Image size 2352x1568.
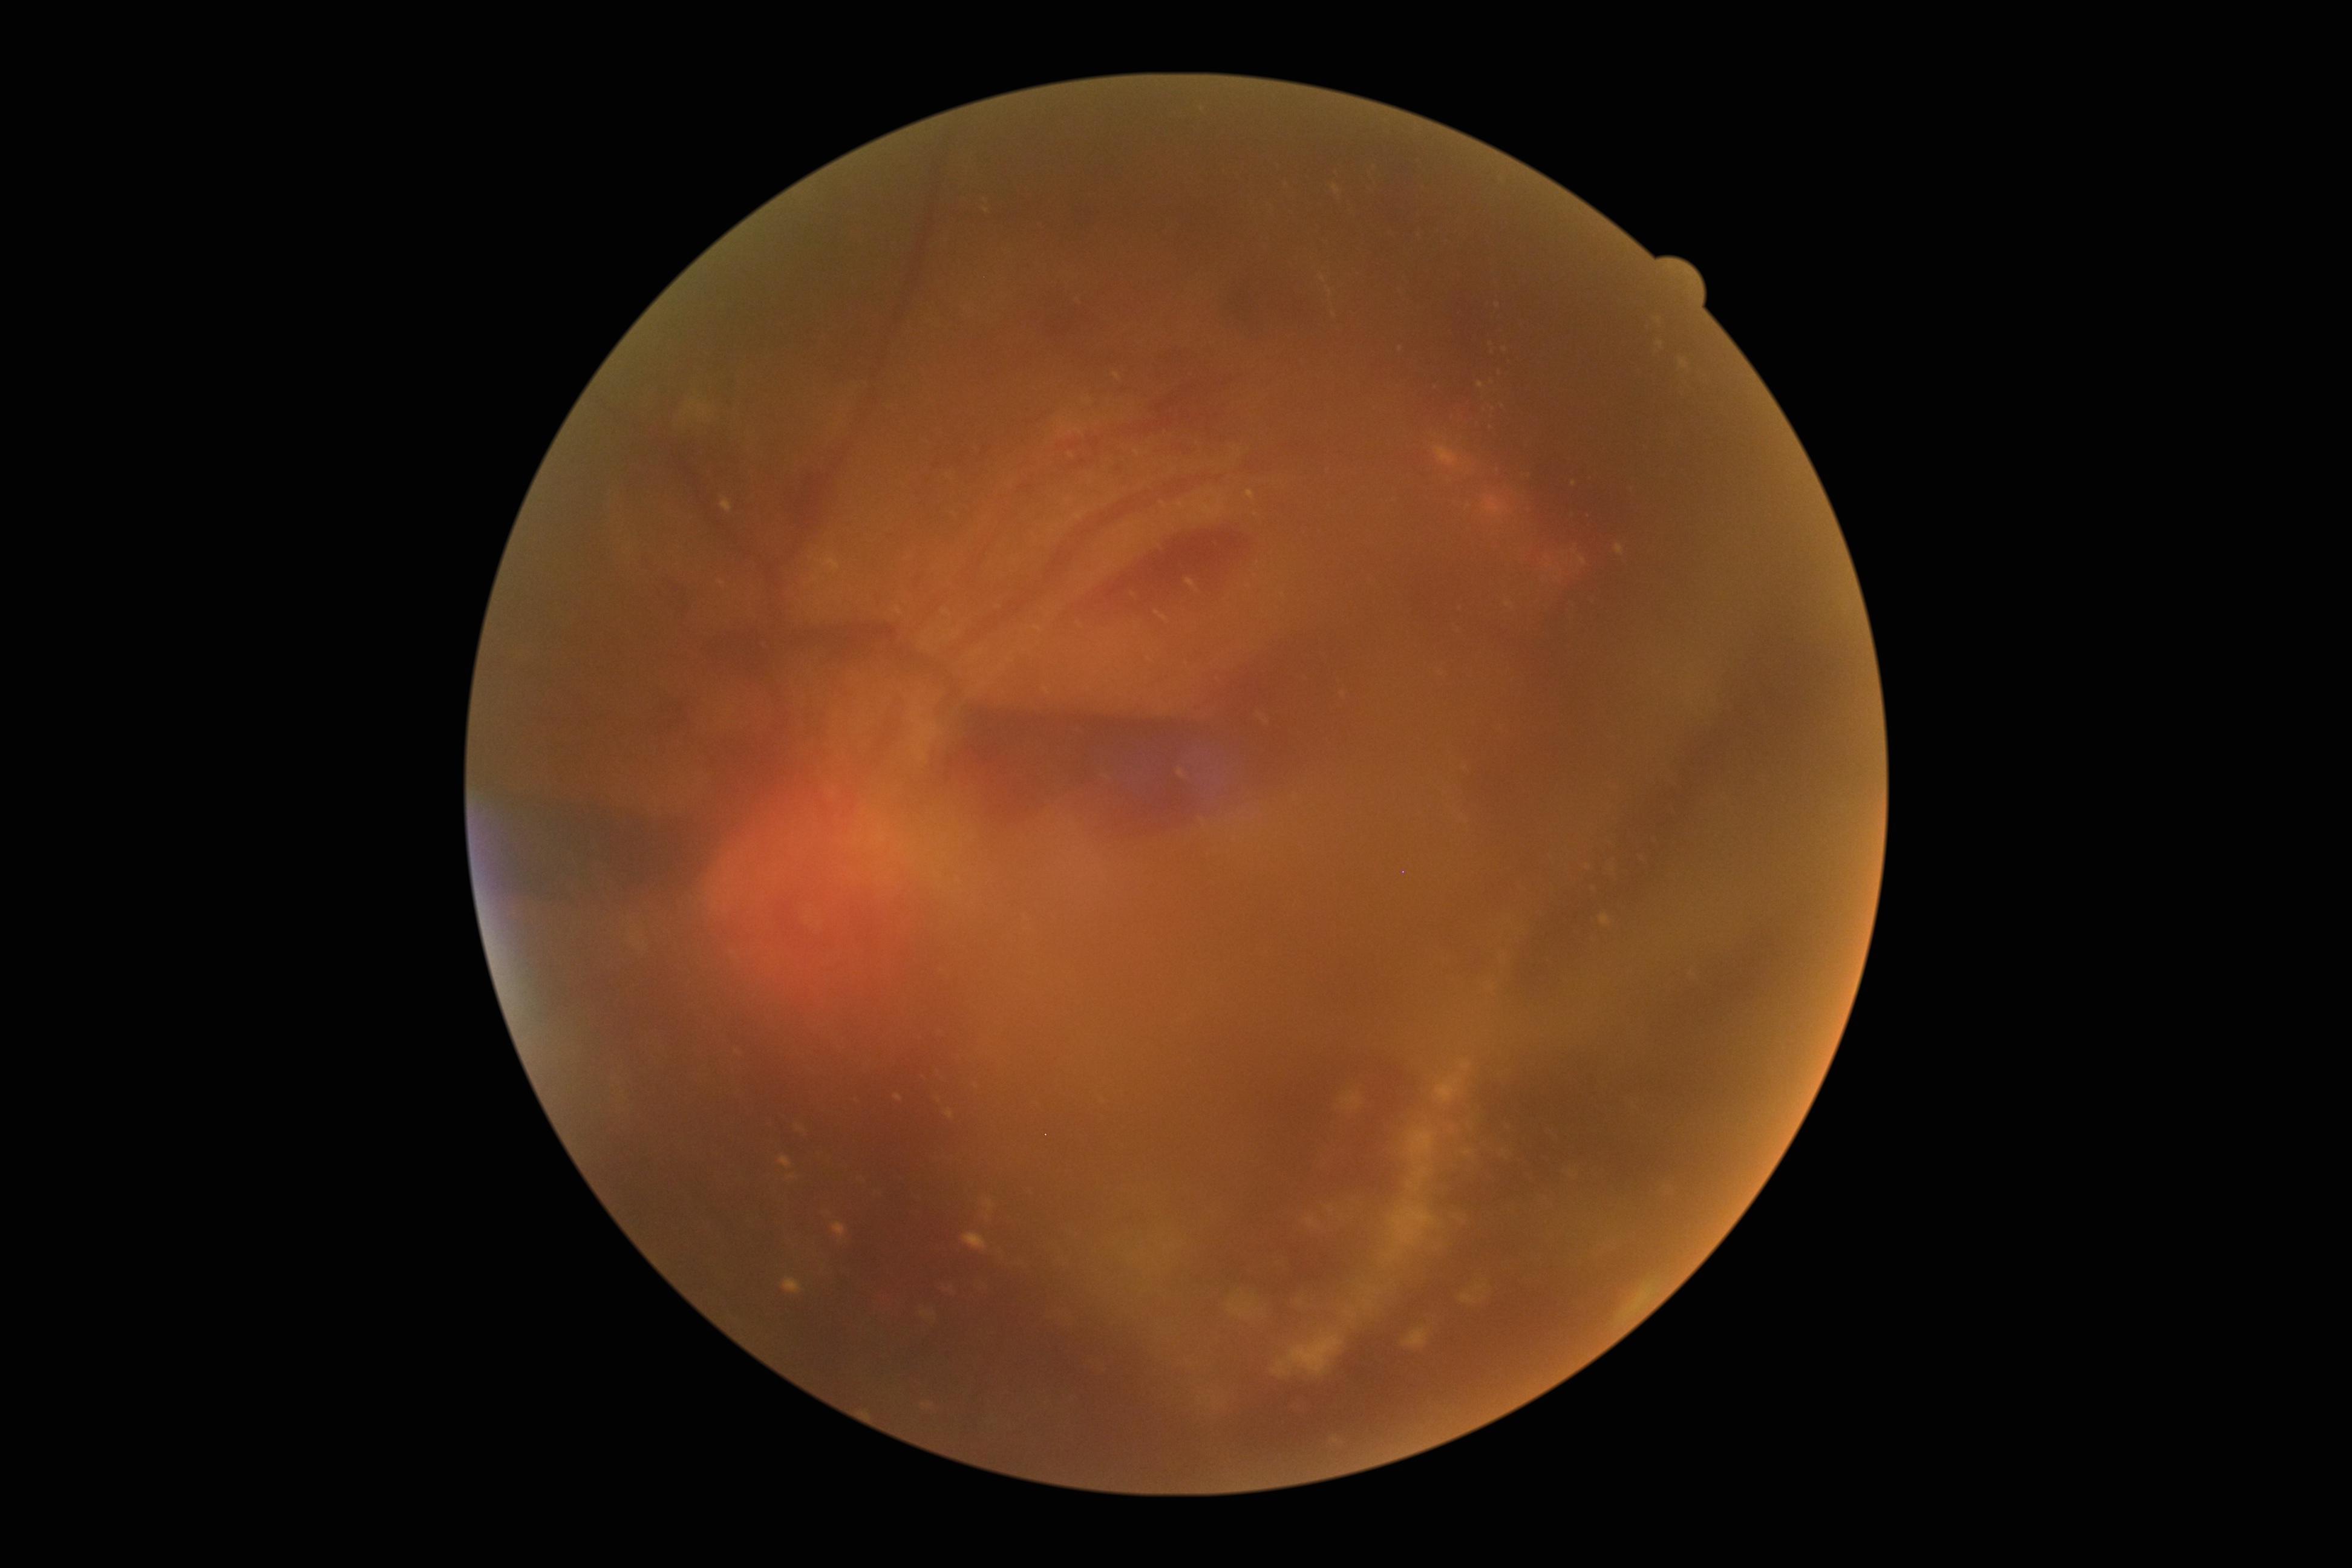

Diabetic retinopathy is 4.